Modified Davis grading. NIDEK AFC-230 — 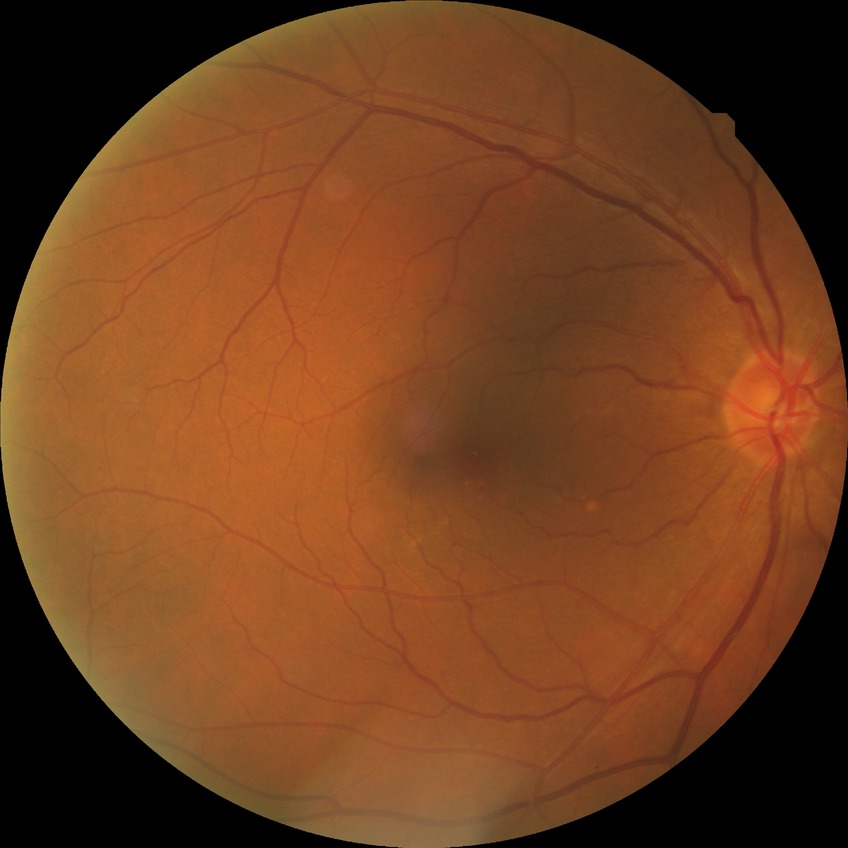
  dr_impression: negative for DR
  davis_grade: NDR